Wide-field fundus image from infant ROP screening. 640x480px. Acquired on the Clarity RetCam 3:
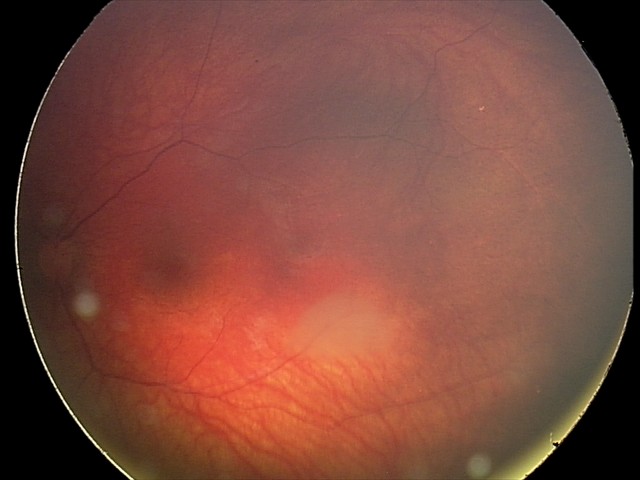
Diagnosis: retinal astrocytic hamartoma